Diabetic retinopathy graded by the modified Davis classification · 848x848px — 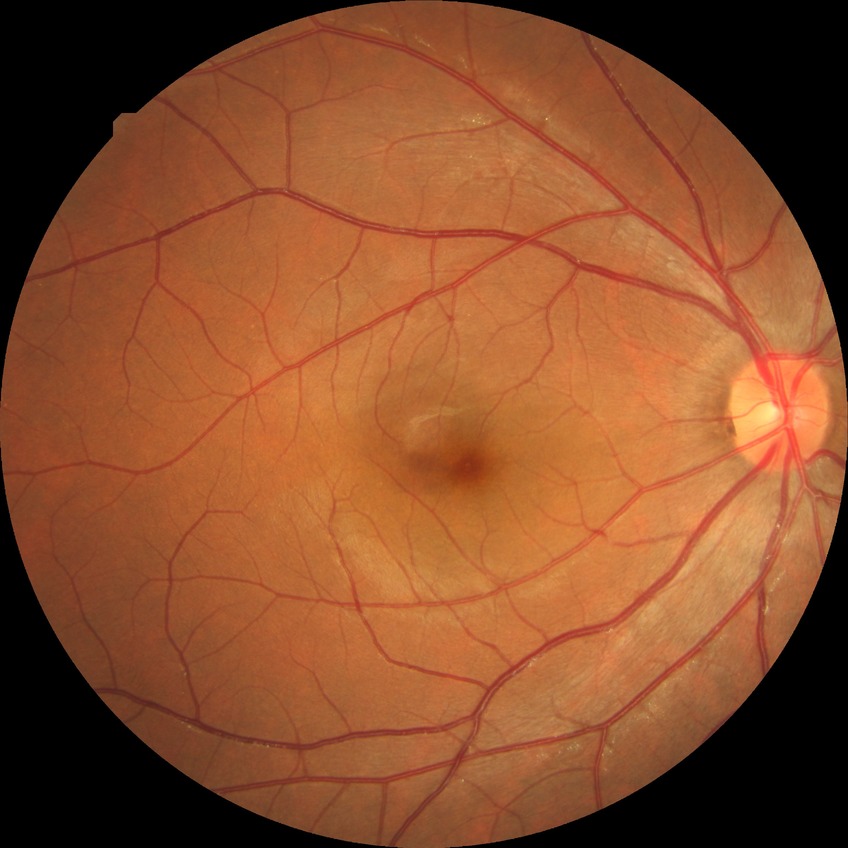

Modified Davis classification: no diabetic retinopathy.